Image size 1240x1240 · pediatric retinal photograph (wide-field) · Phoenix ICON, 100° FOV.
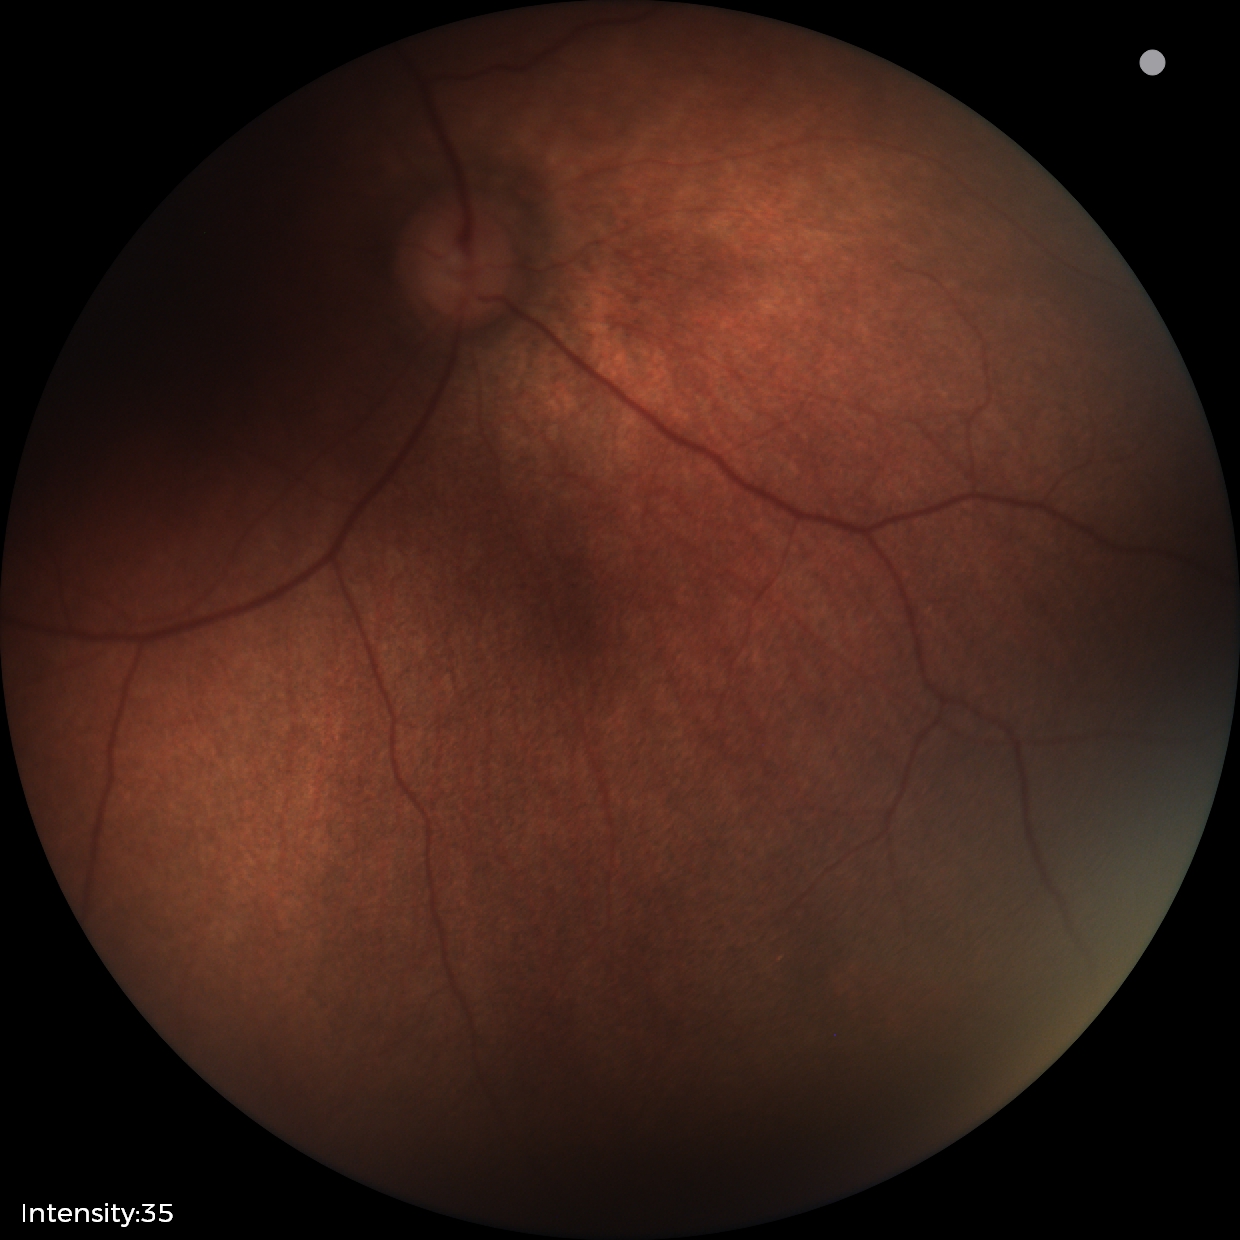
Physiological retinal appearance for postconceptual age.